Image size 2361x1568. 45° field of view. Color fundus image — 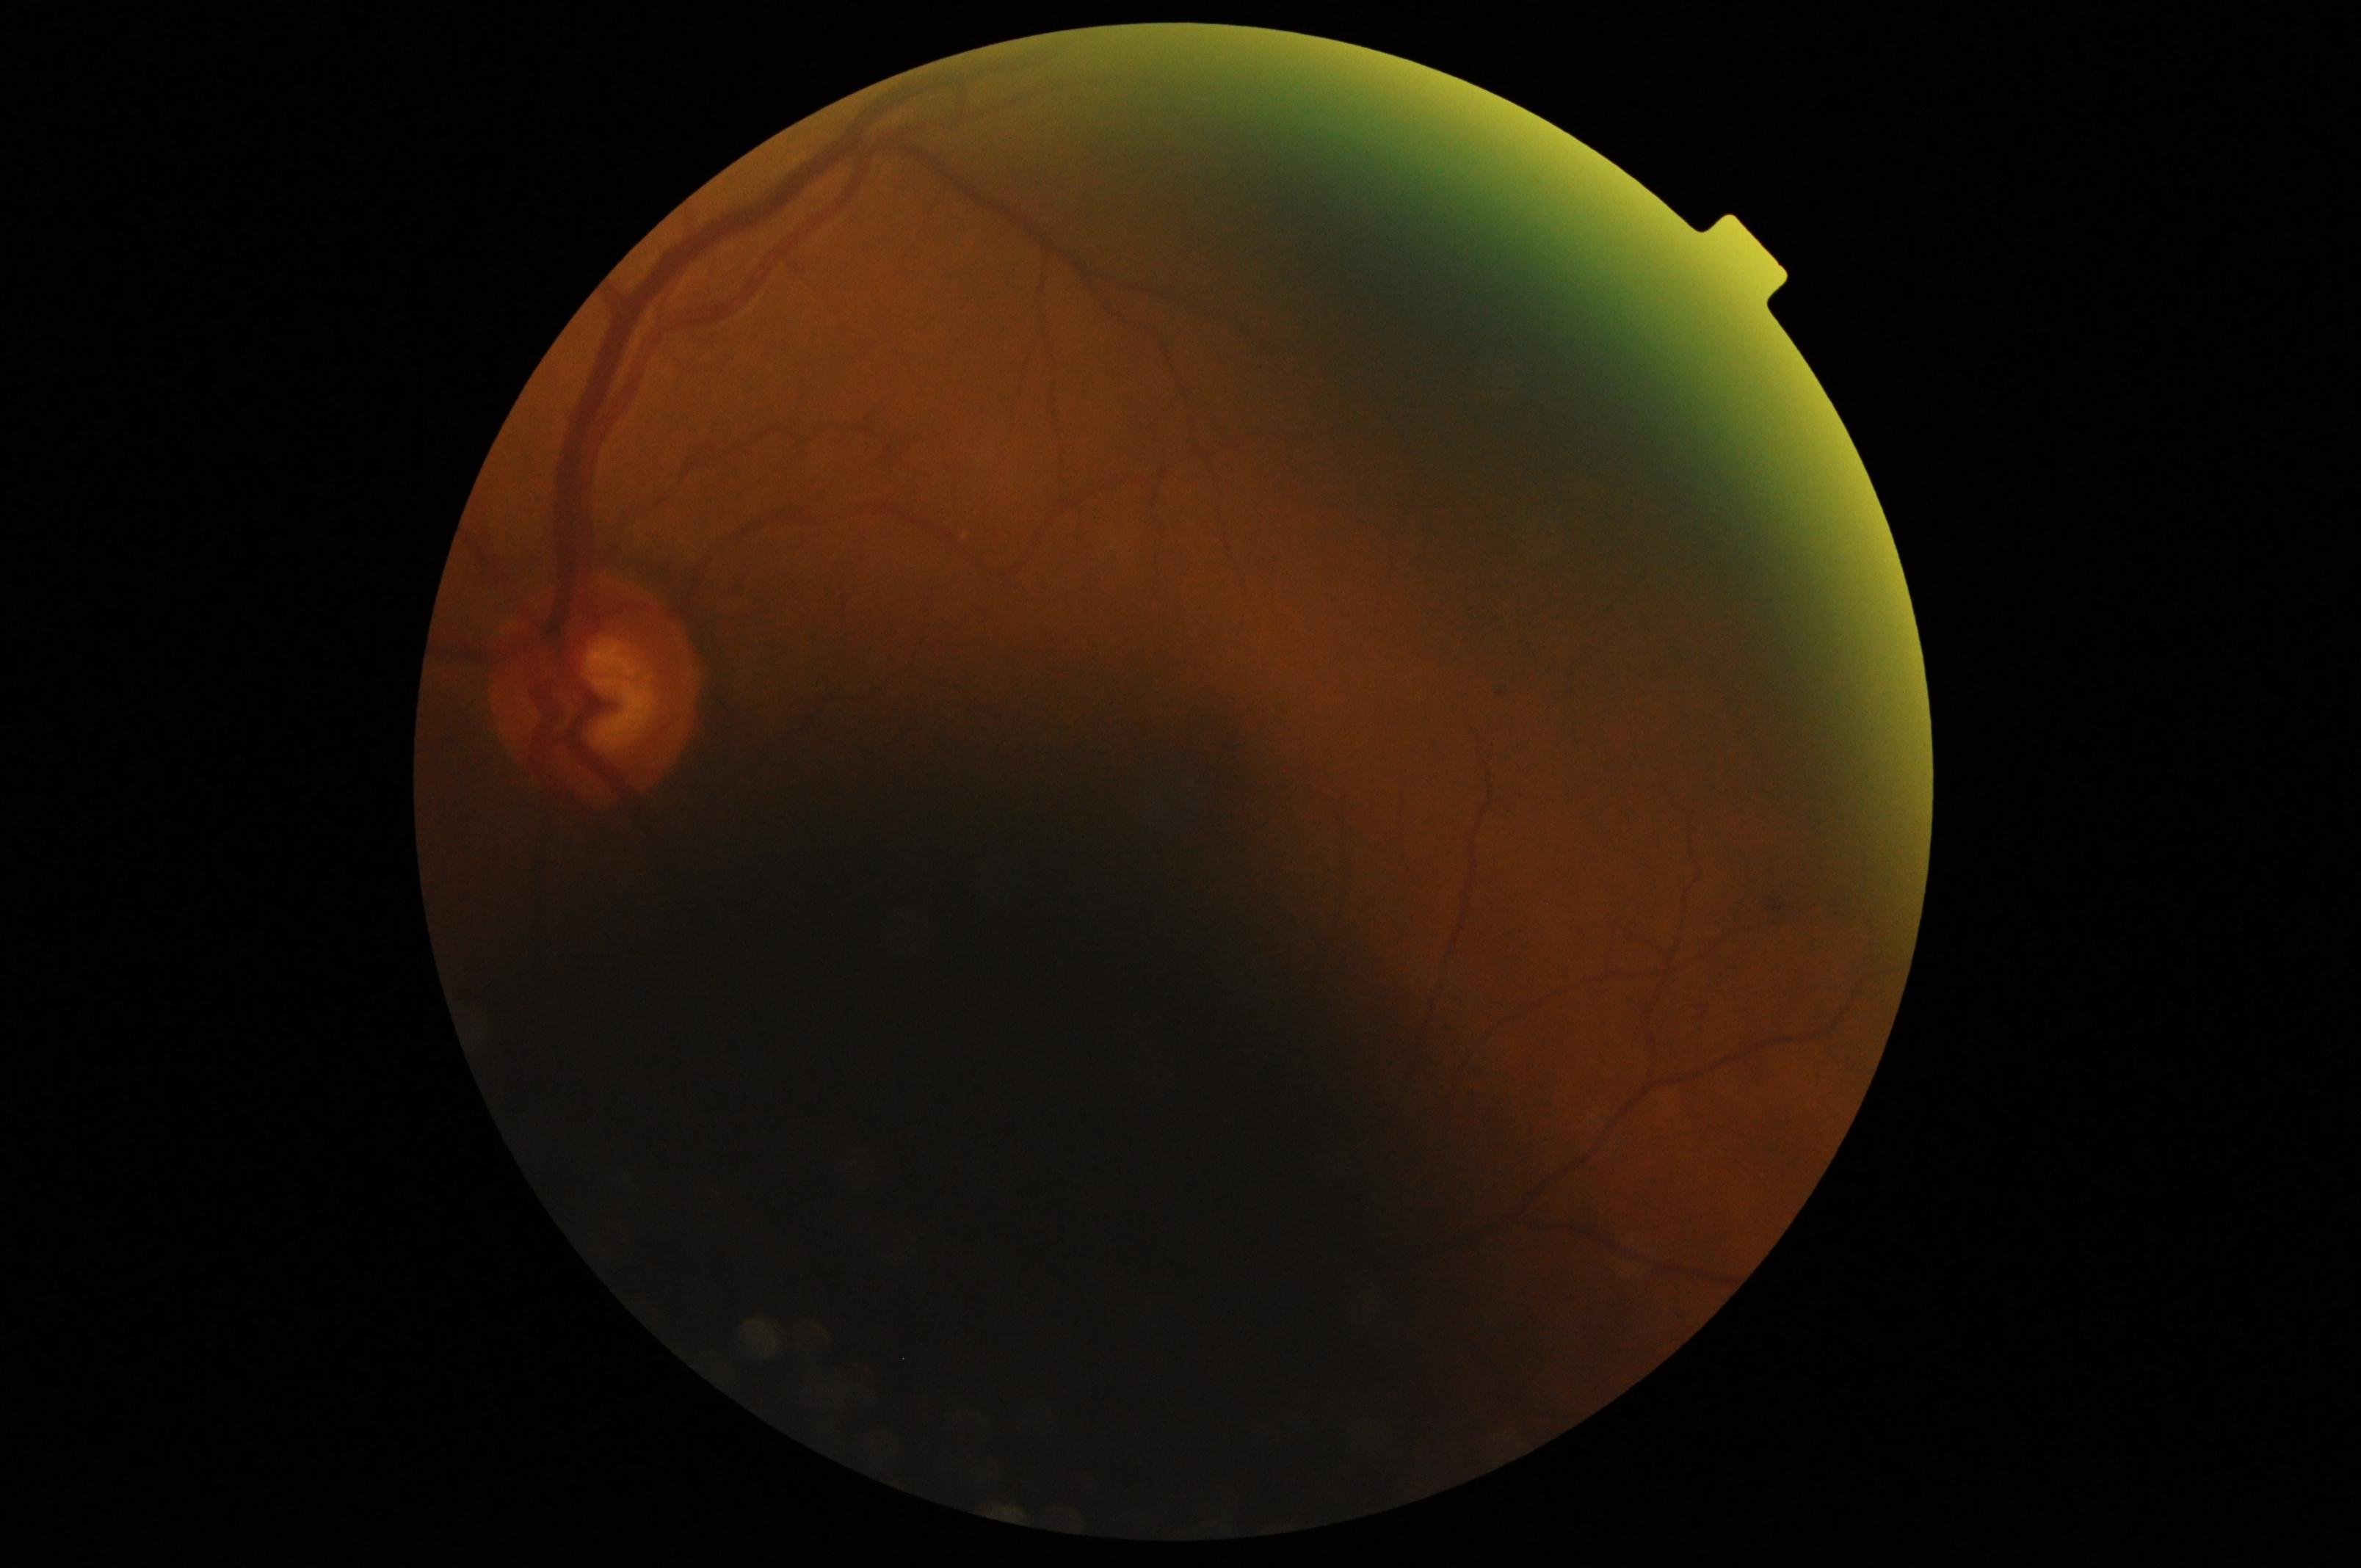

diabetic retinopathy@grade 2.